848x848px: 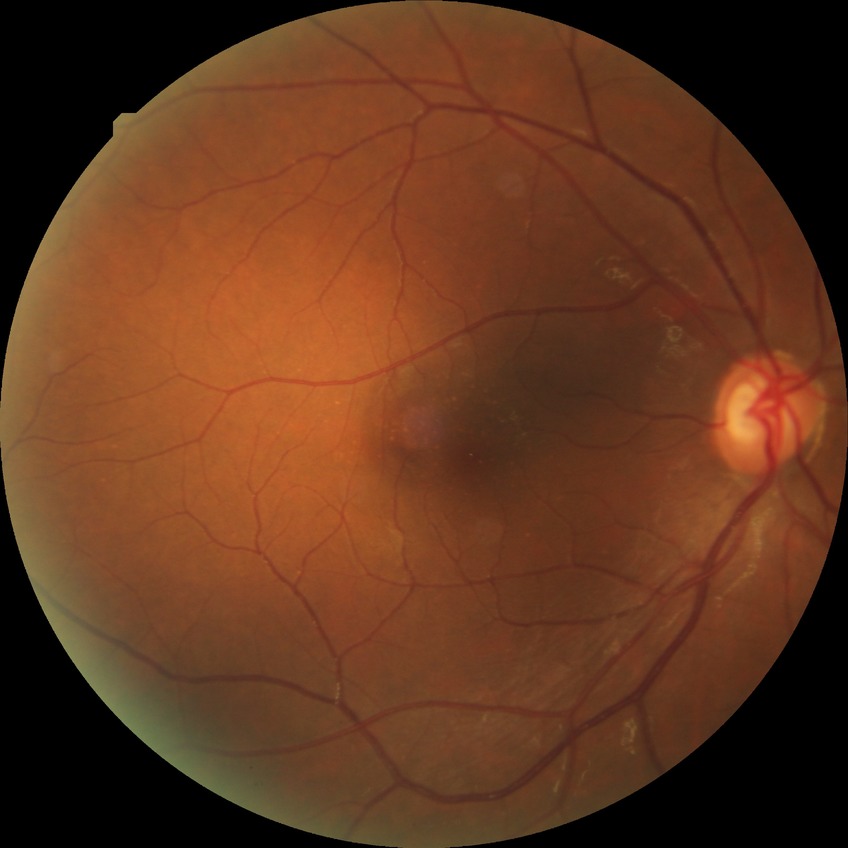
diabetic retinopathy (DR): NDR (no diabetic retinopathy).